Wide-field fundus image from infant ROP screening
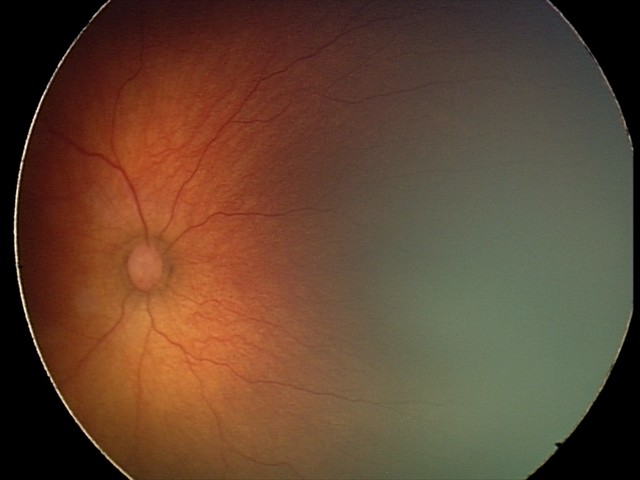

Examination diagnosed as ROP stage 2.